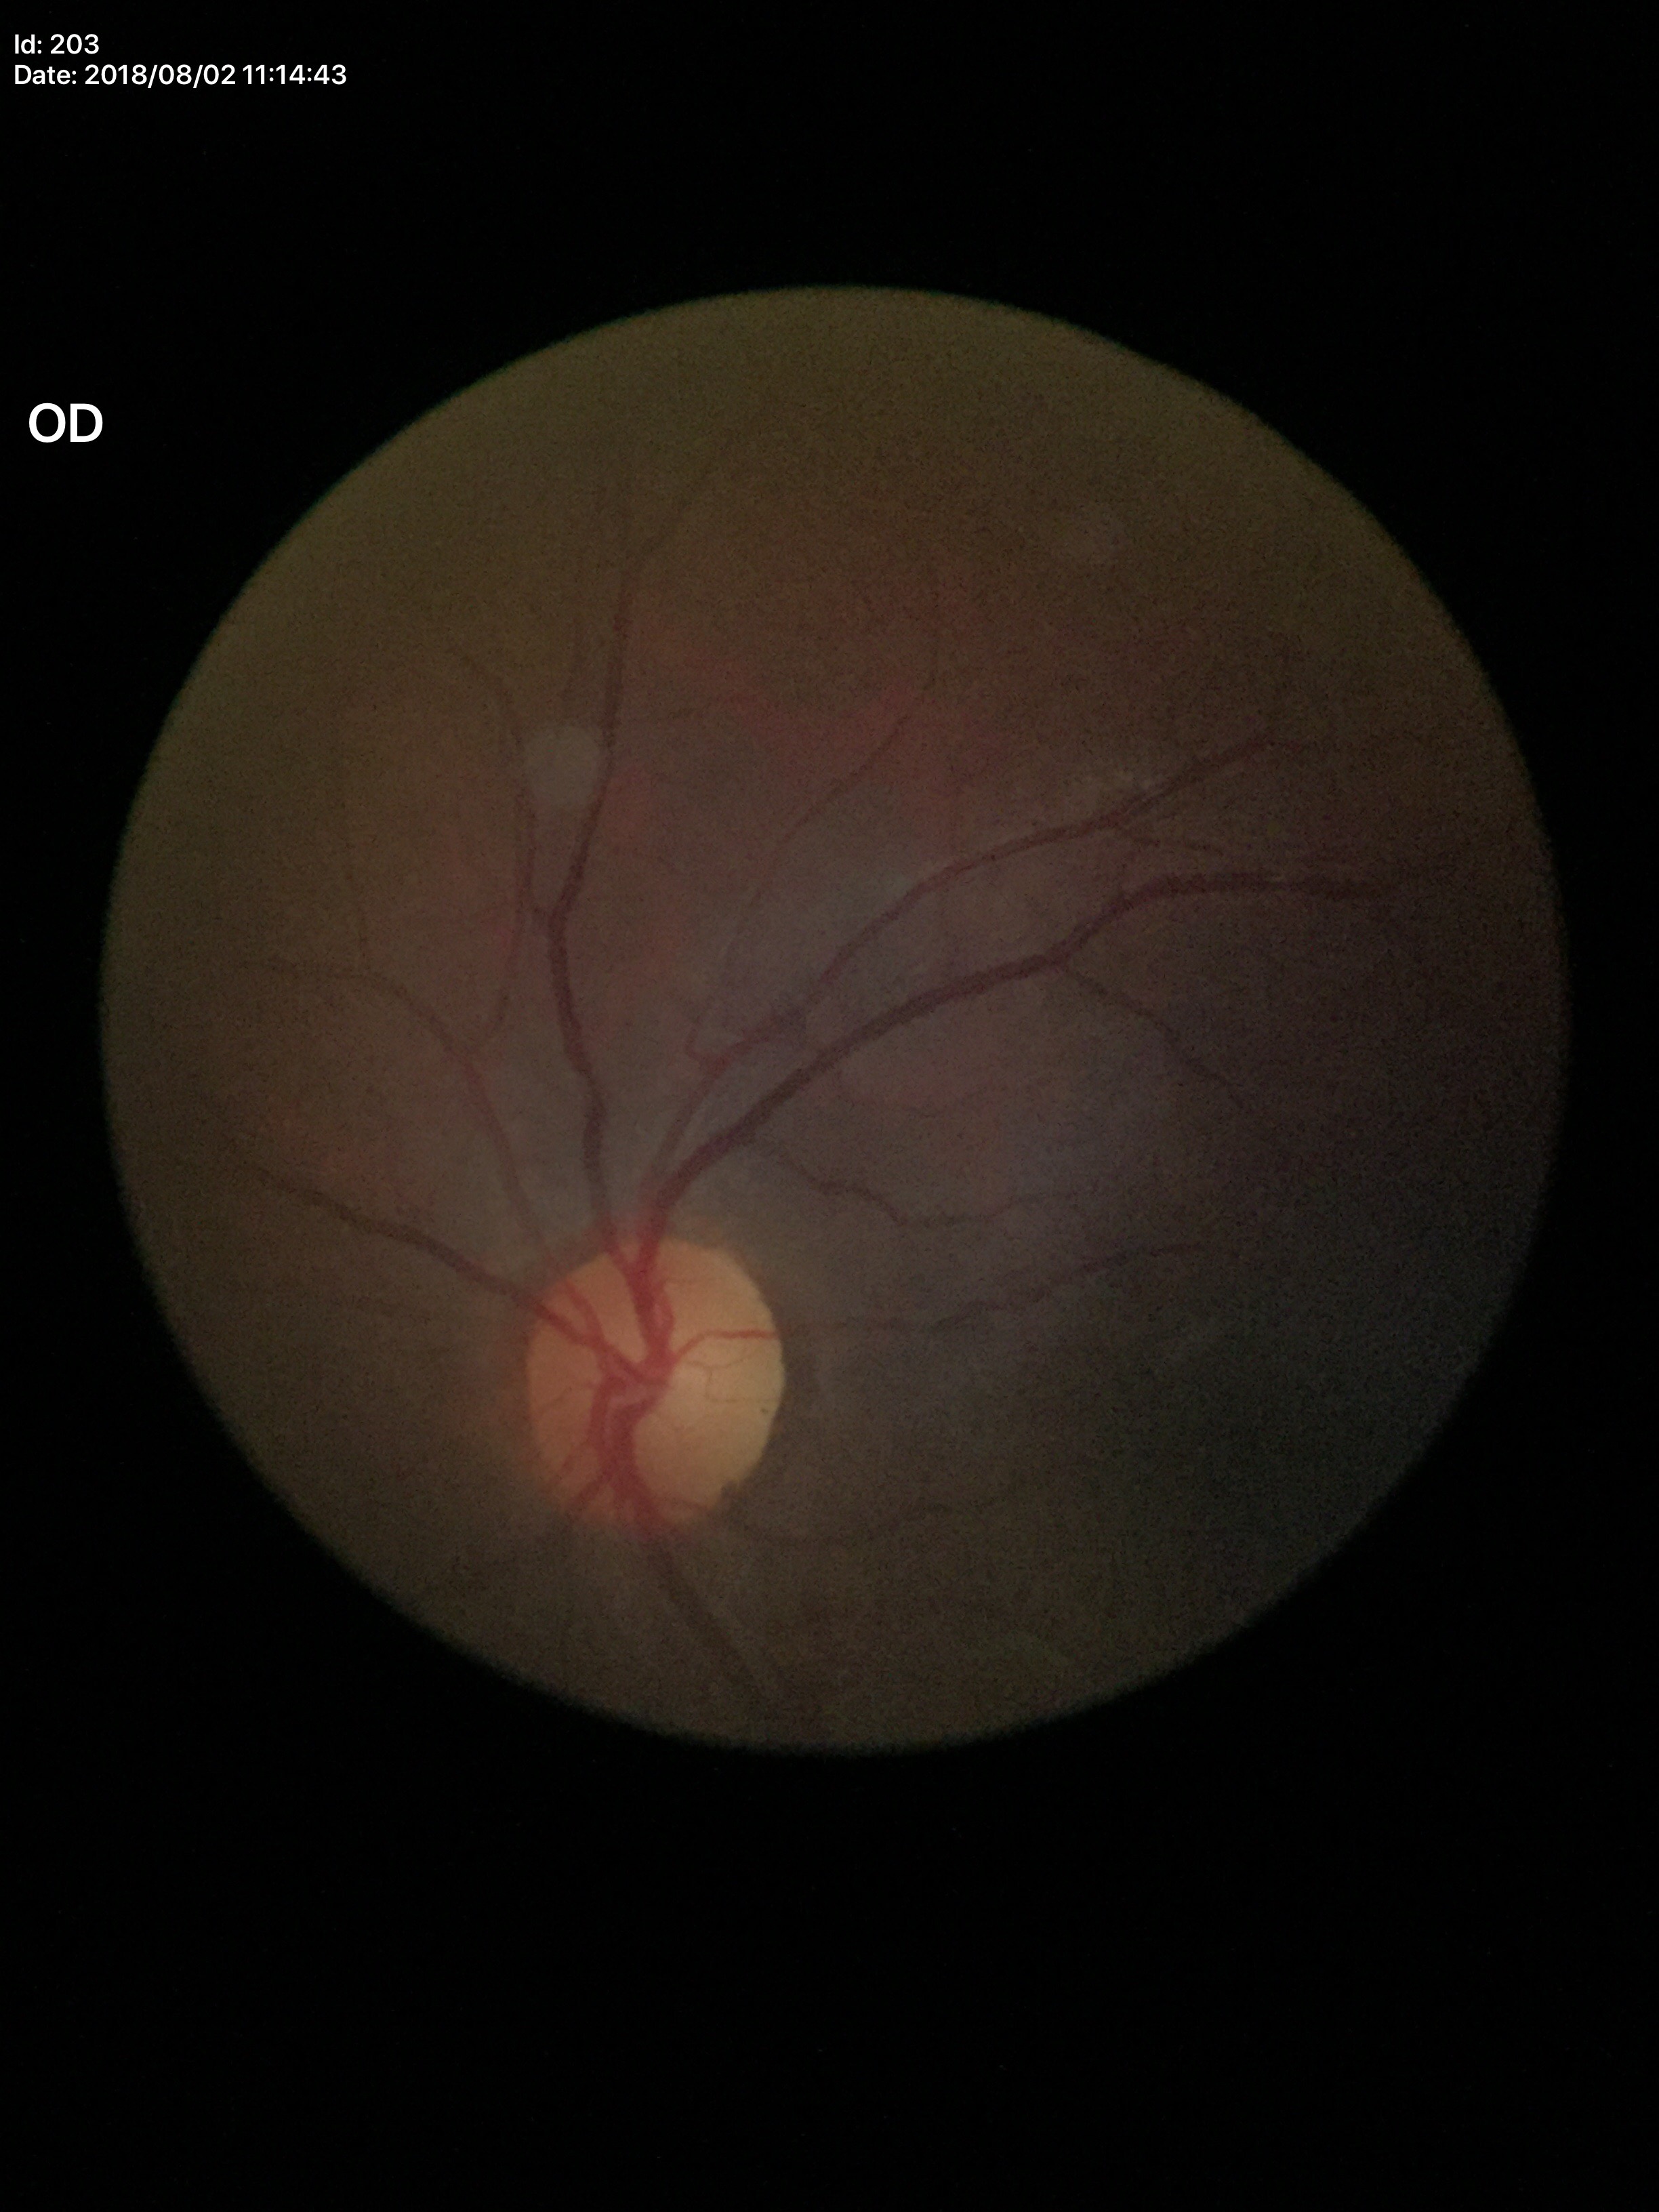

– Glaucoma evaluation — negative (all 5 graders called normal)
– vertical cup-disc ratio — 0.44